45° FOV — 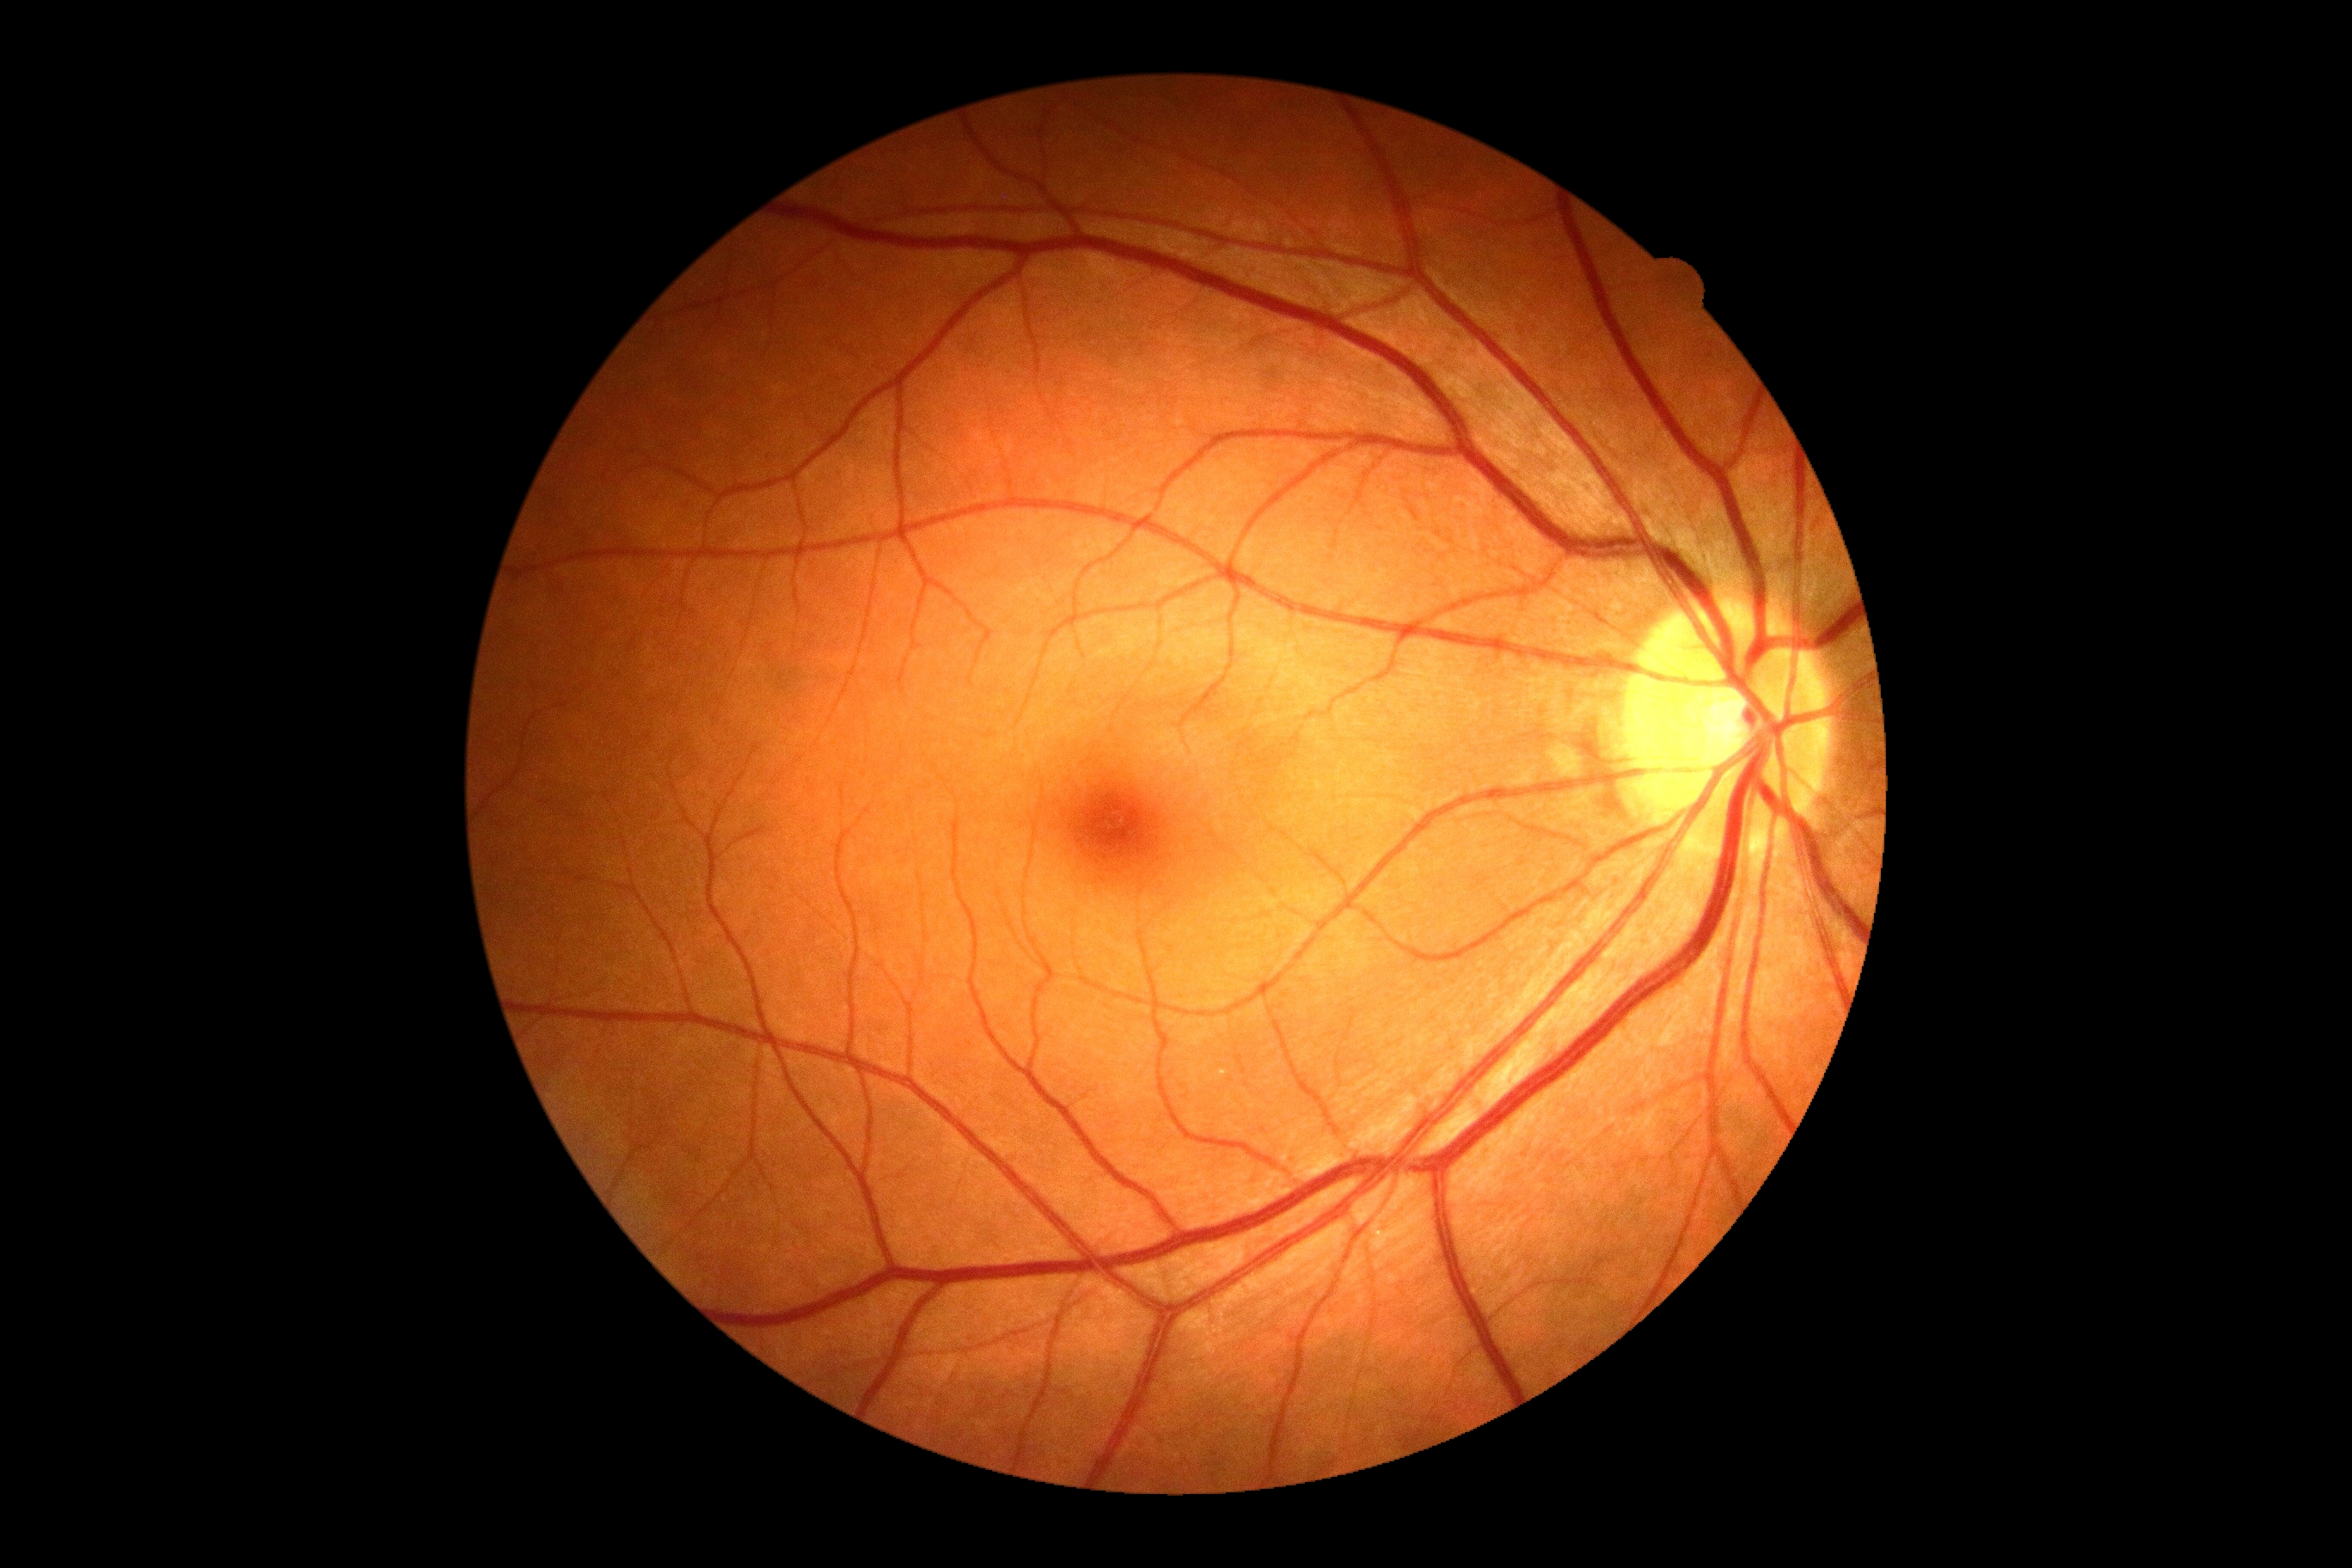

DR severity is 0 — no visible signs of diabetic retinopathy.